Captured on a Nidek AFC-330 fundus camera: 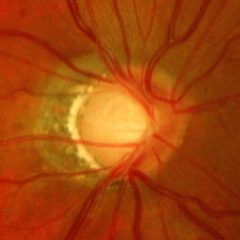
Glaucomatous changes are present. The image shows advanced-stage glaucoma. Defined as near-total cupping of the optic nerve head, with or without severe visual field loss within the central 10 degrees of fixation.